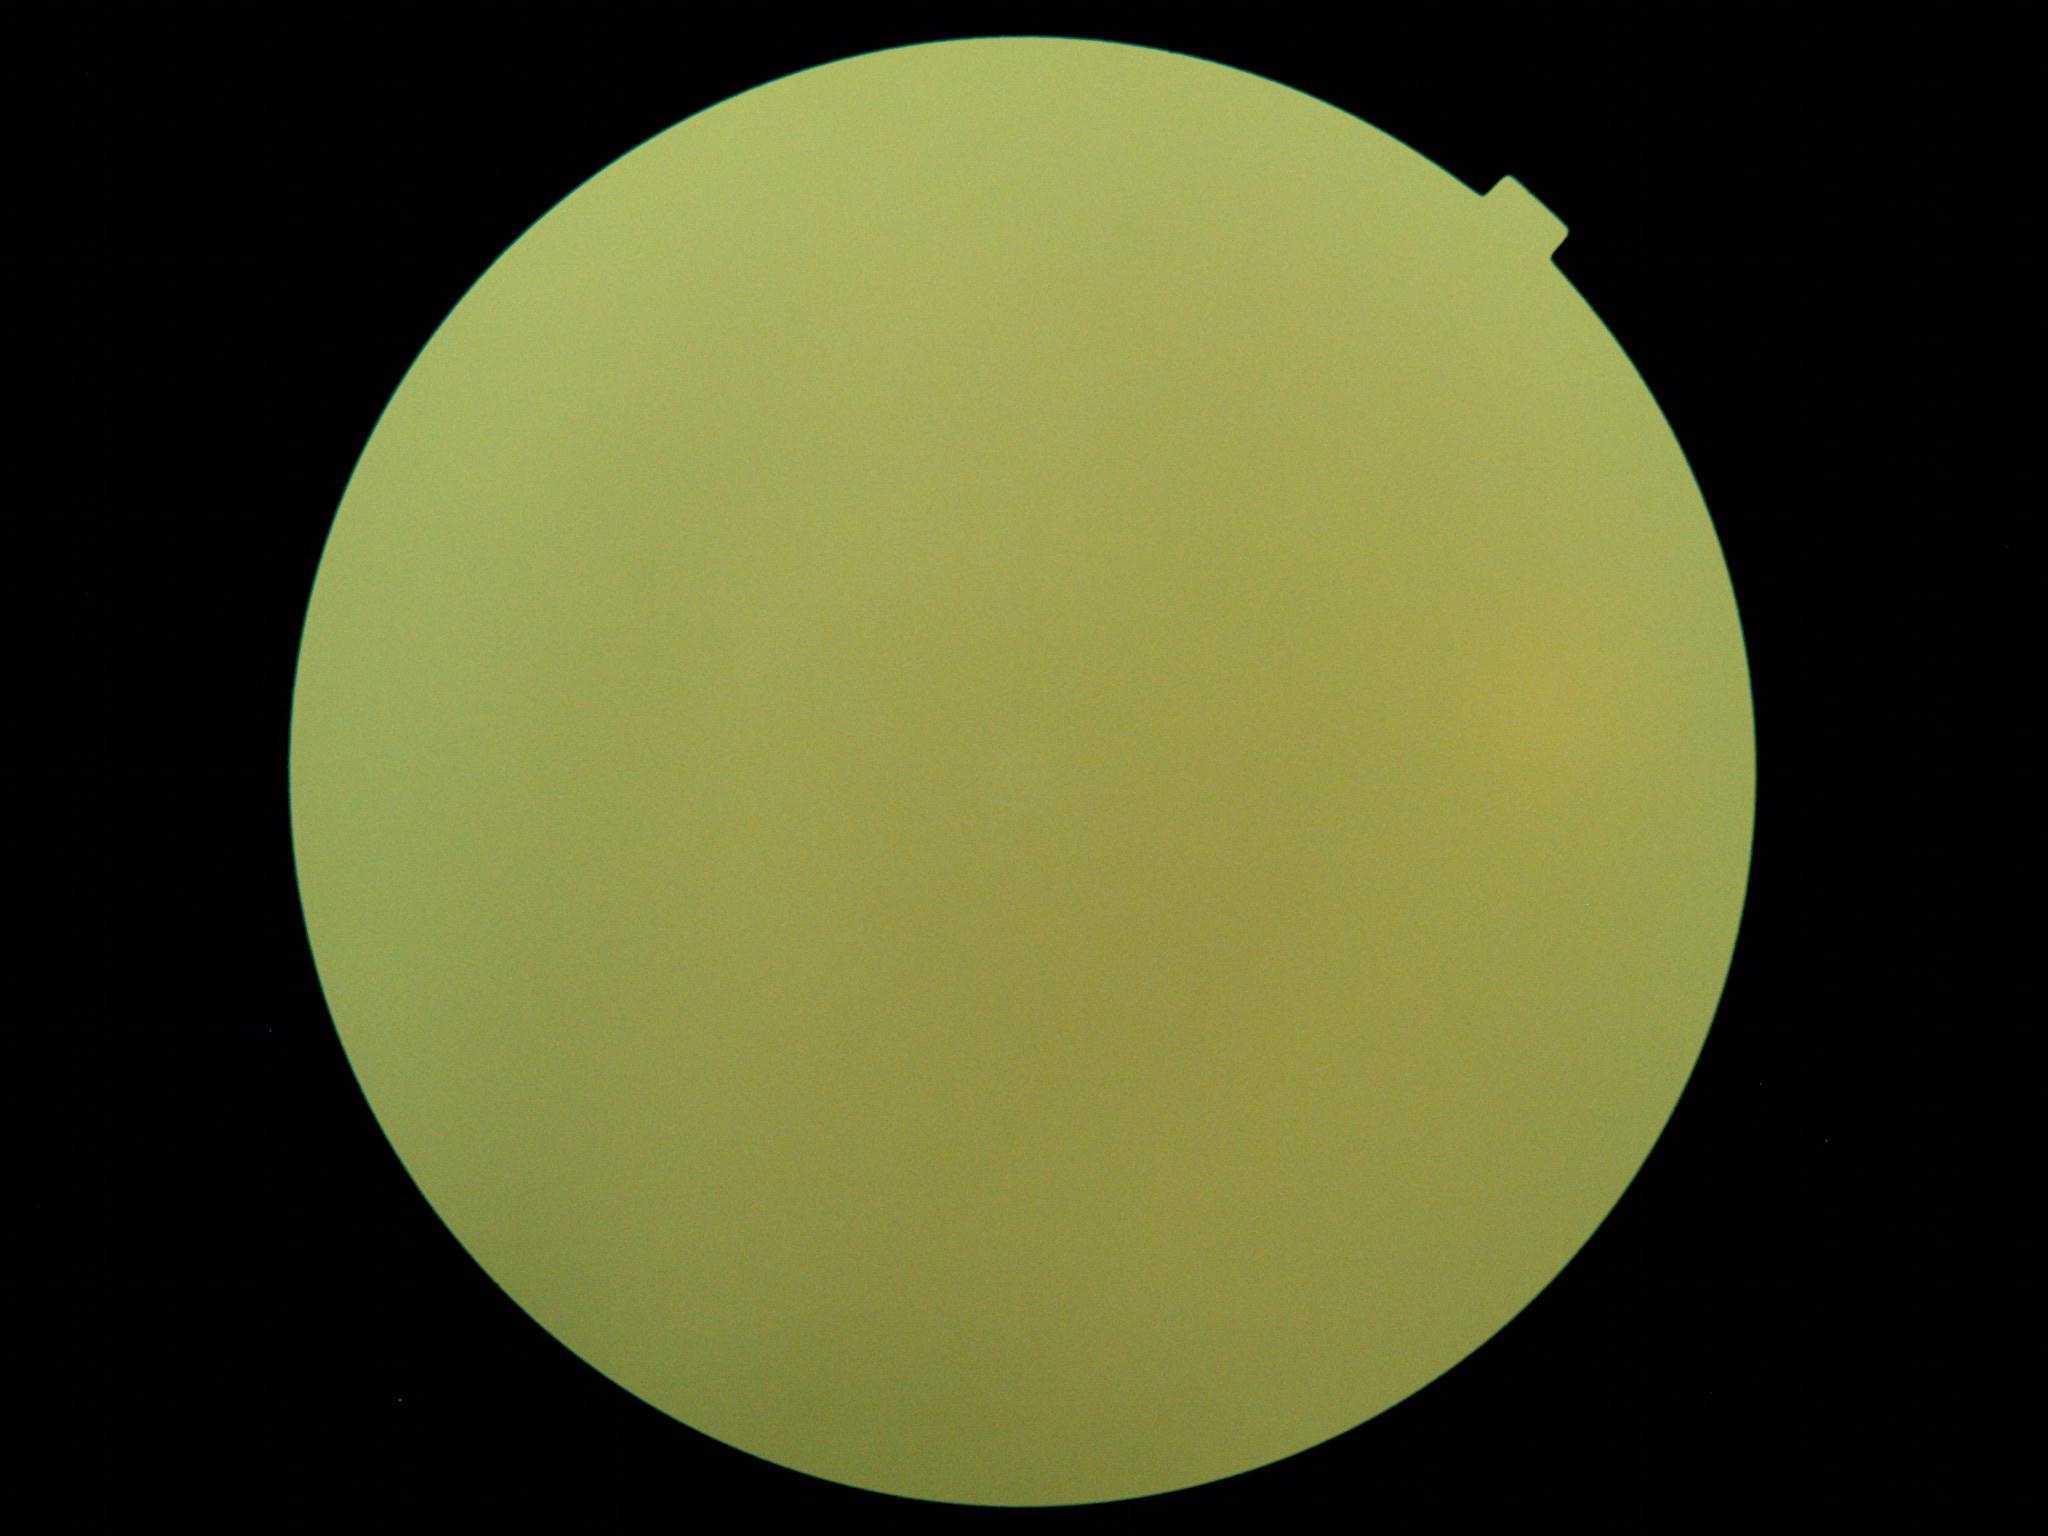
DR stage is ungradable due to poor image quality.